640 by 480 pixels. Wide-field fundus photograph of an infant. Clarity RetCam 3, 130° FOV — 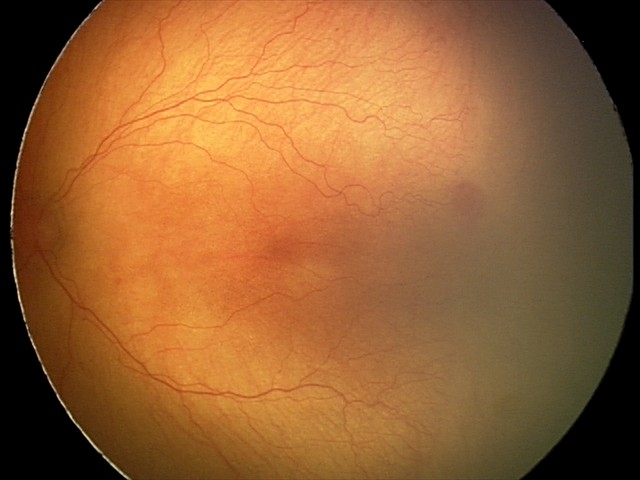
With plus disease.
Series diagnosed as A-ROP (aggressive ROP) — rapidly progressive severe ROP with prominent plus disease, often without classic stage progression.